Image size 640x480. Camera: Clarity RetCam 3 (130° FOV). Pediatric retinal photograph (wide-field).
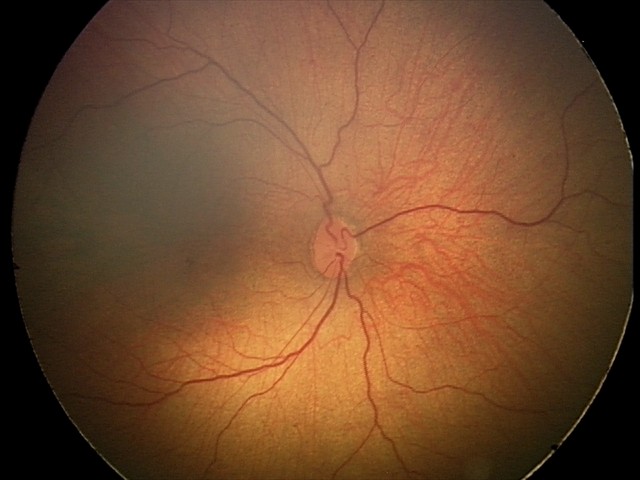
Q: What is the diagnosis from this examination?
A: physiological retinal finding